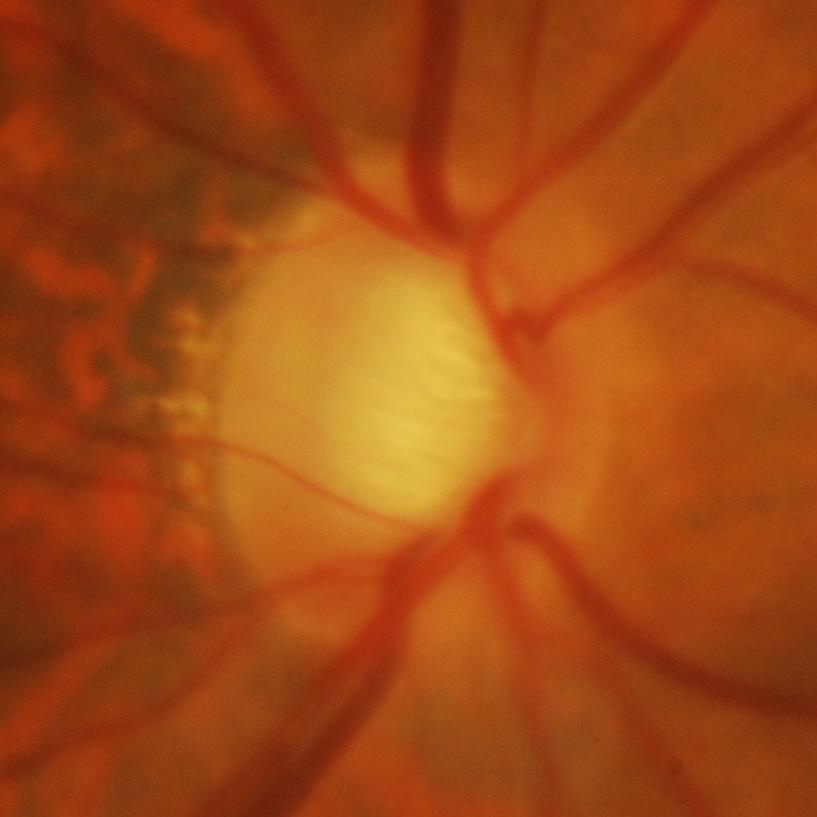
Diagnosis: evidence of glaucoma.